45° FOV; CFP; 1472x1474:
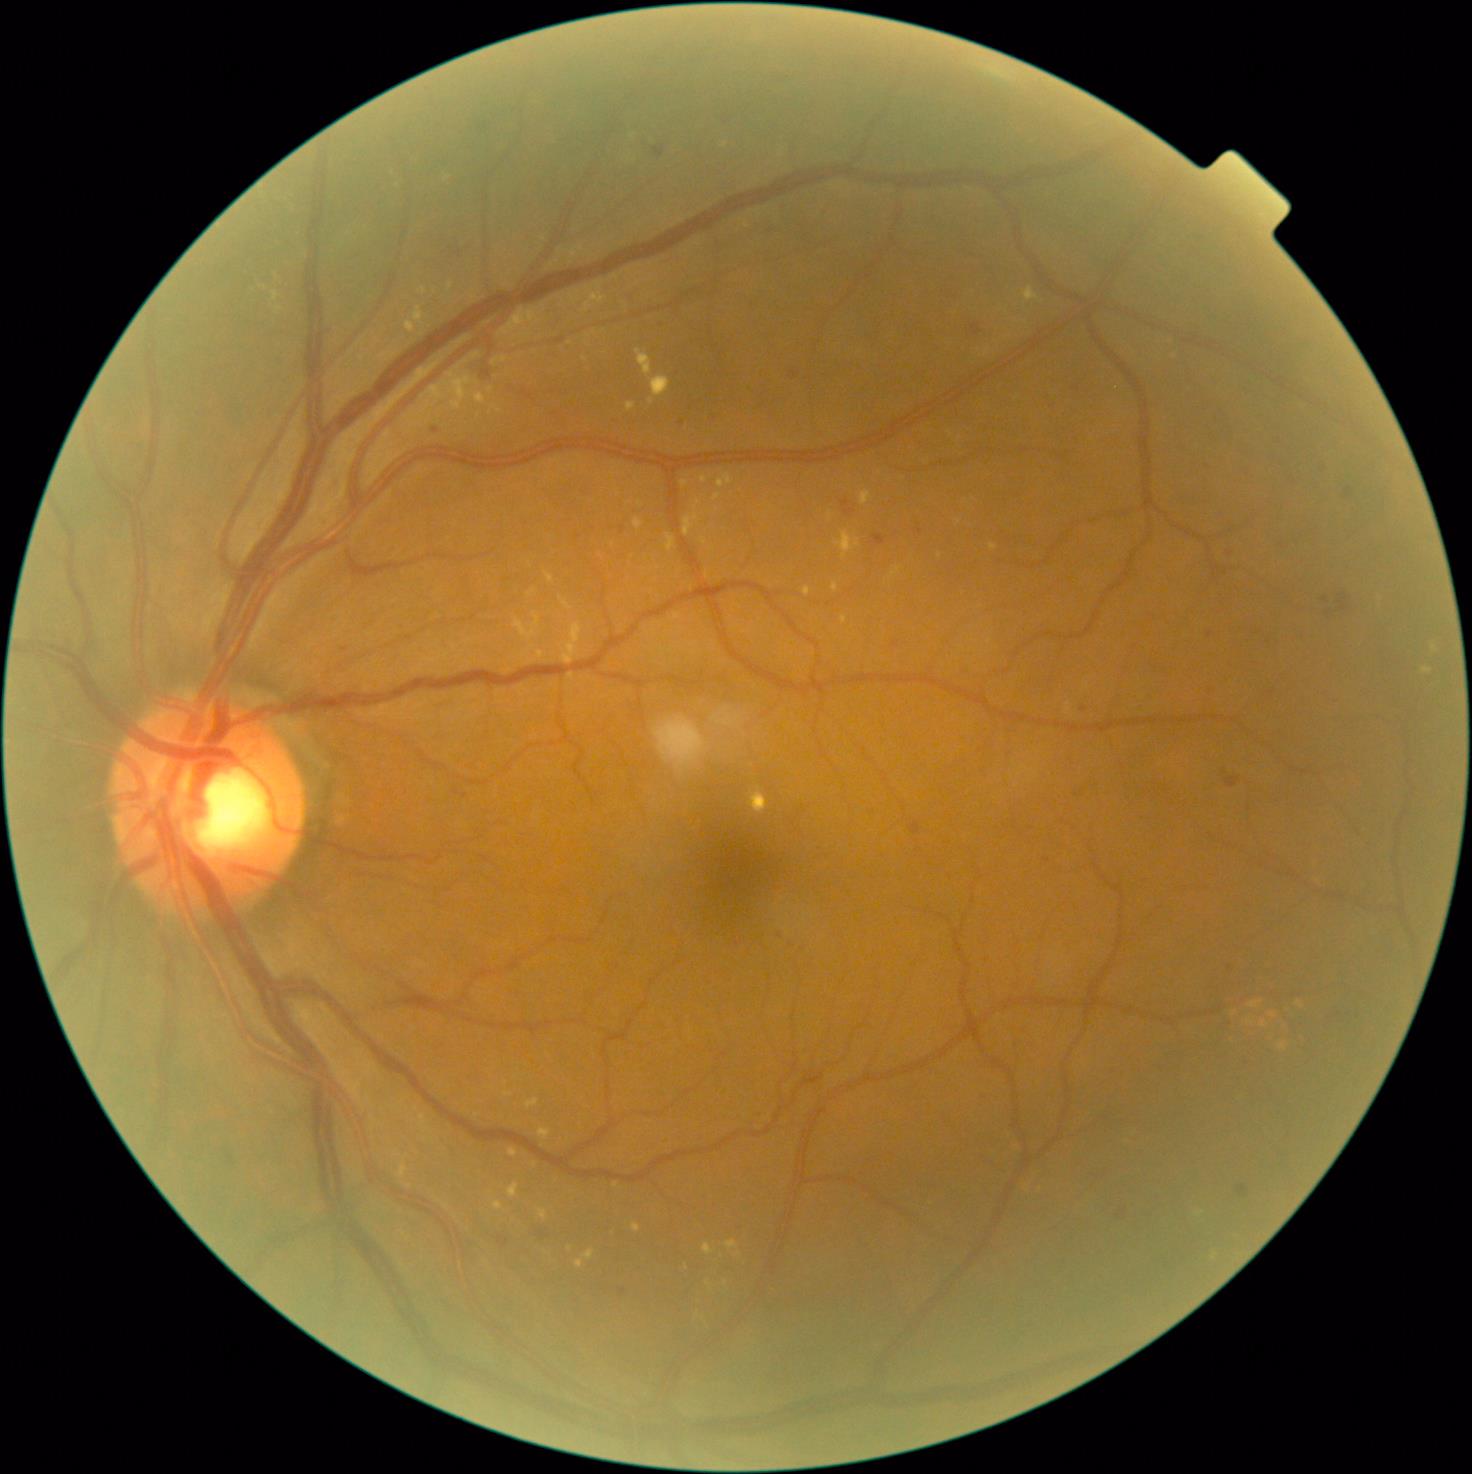
Diabetic retinopathy (DR): moderate NPDR (grade 2)
Lesions identified (partial list):
hard exudates (EXs) (subset) = [539,1128,552,1139] | [832,583,839,592] | [637,349,652,376] | [585,1250,595,1260] | [634,518,644,530] | [494,1201,503,1210] | [842,616,848,624] | [1024,287,1038,302] | [583,287,608,313]
Small EXs near (739, 1254) | (570, 1248) | (940, 556) | (704, 480) | (699, 502) | (279, 310)